Infant wide-field fundus photograph
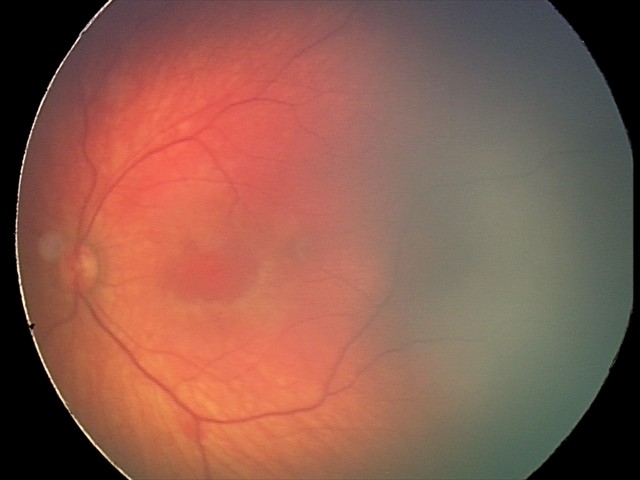

Q: What is the diagnosis from this examination?
A: retinal hemorrhages